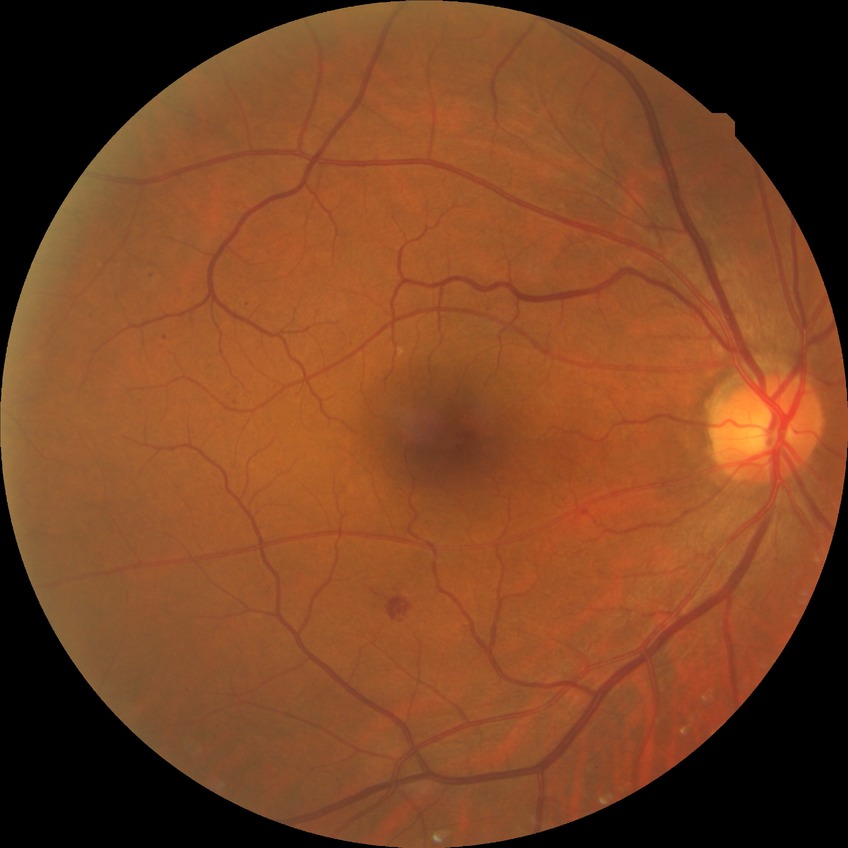

Diabetic retinopathy (DR) is SDR (simple diabetic retinopathy).